Wide-field fundus photograph of an infant. Camera: Natus RetCam Envision (130° FOV): 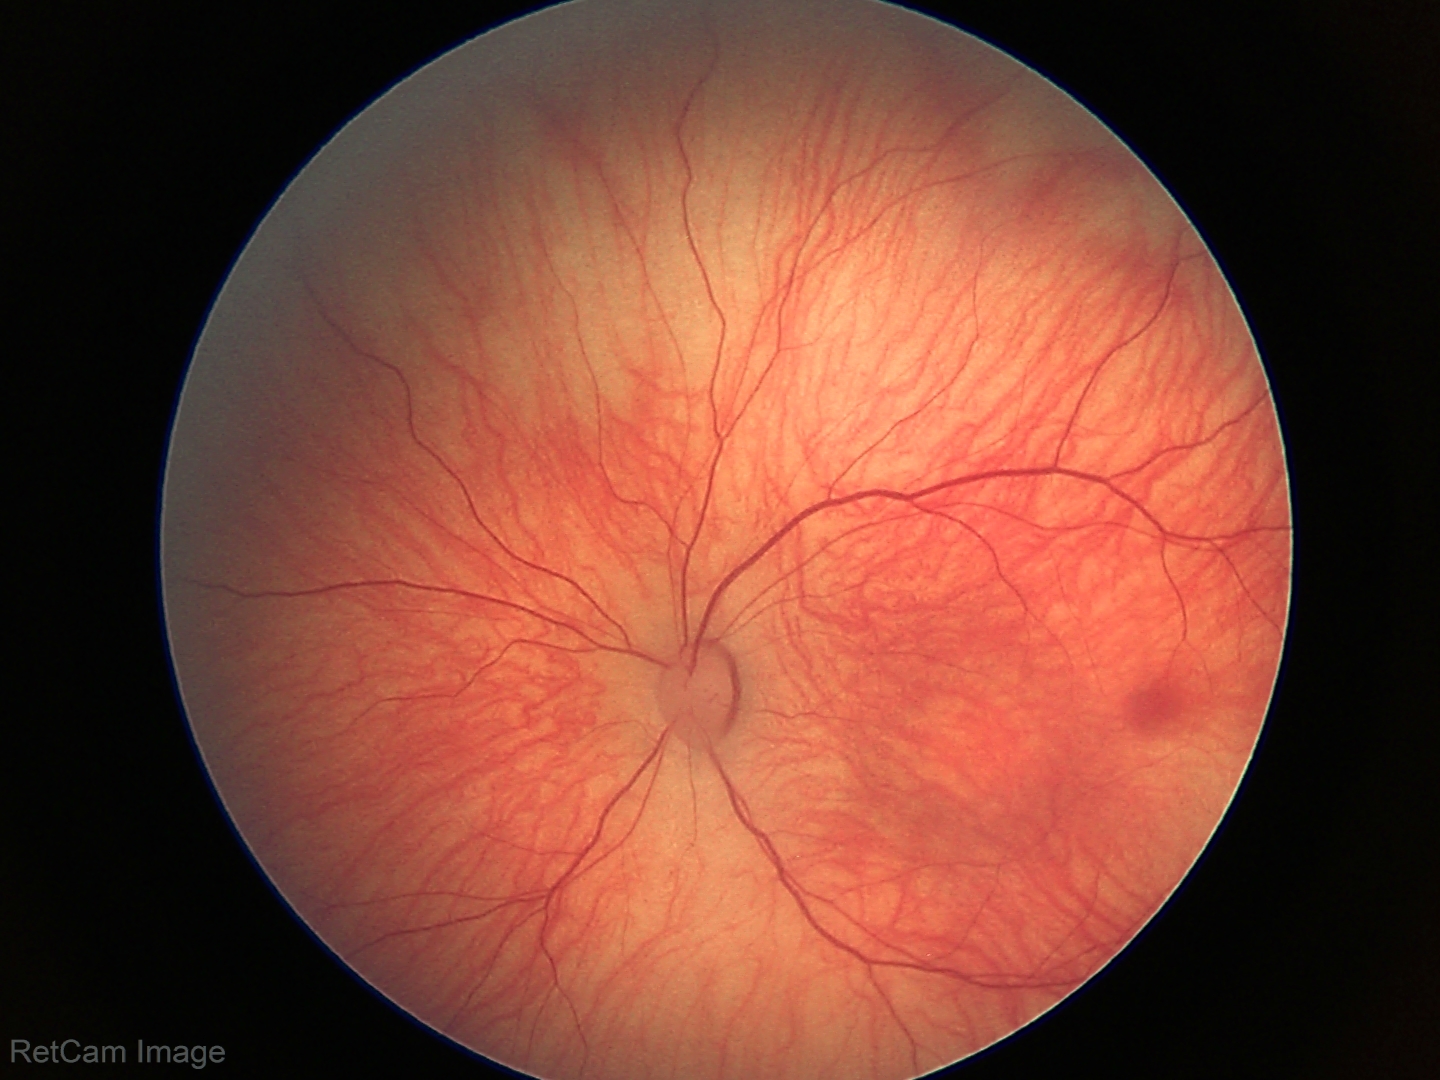 Q: What was the screening finding?
A: physiological appearance with no retinal pathology